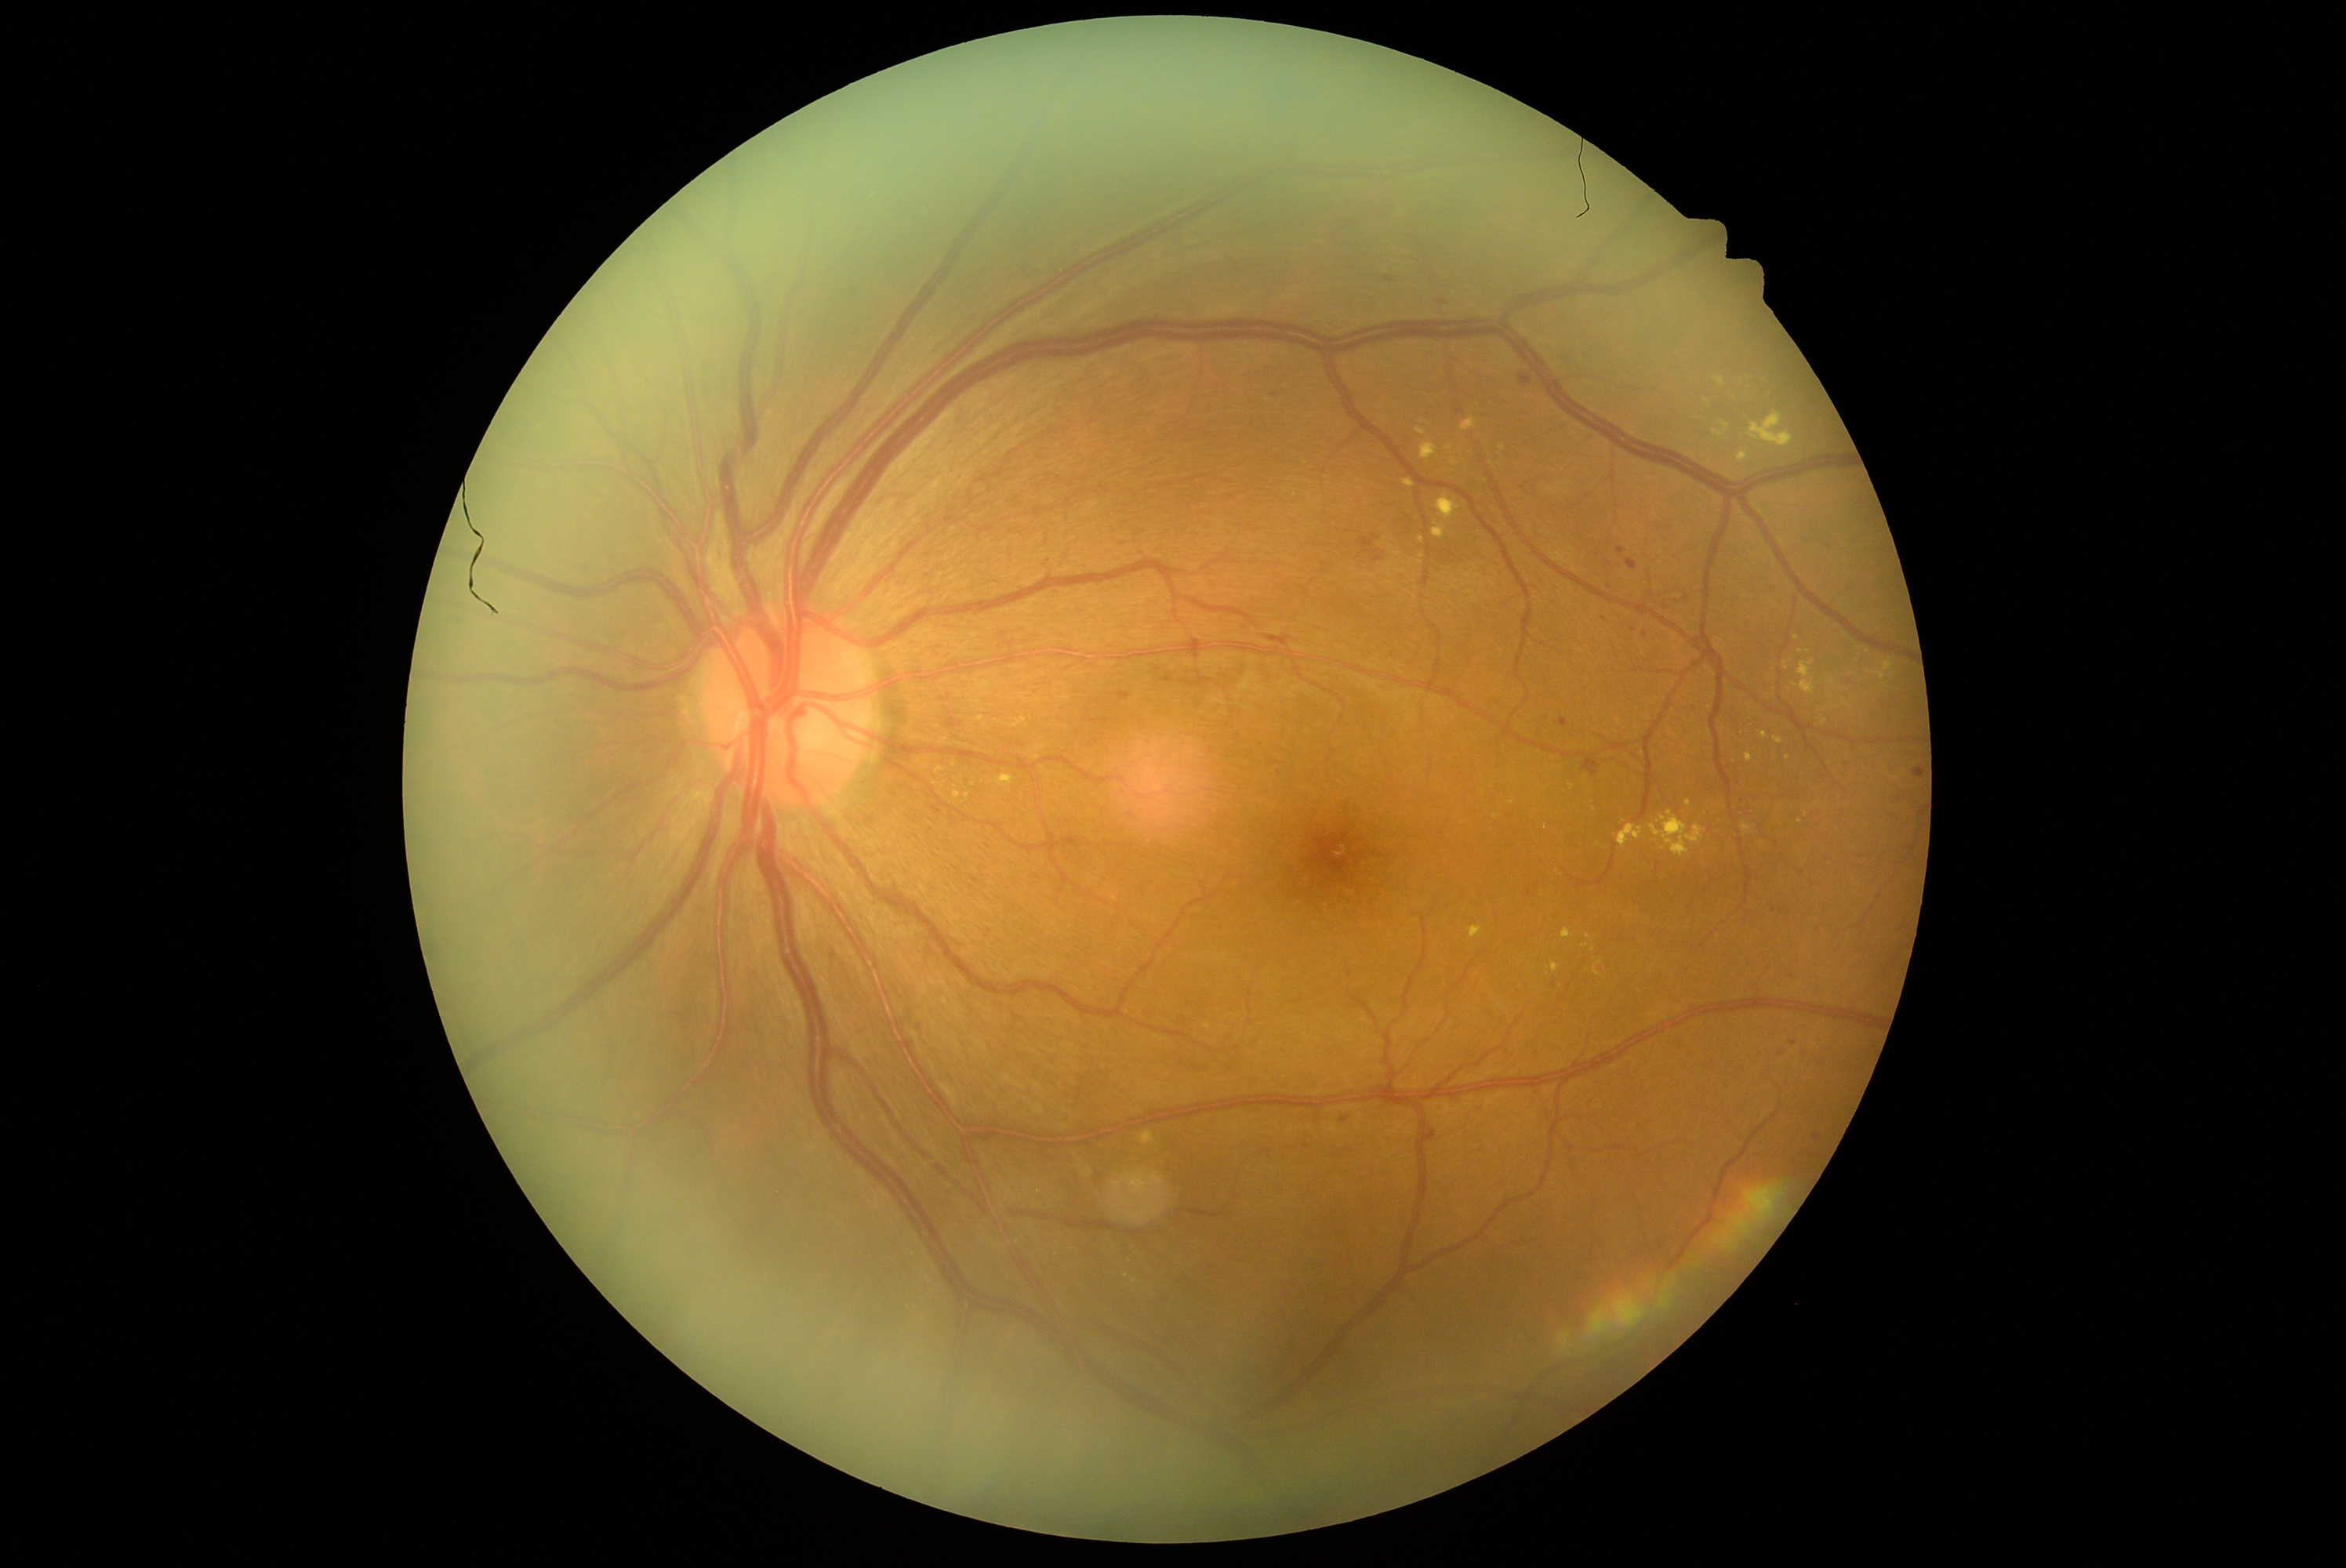 DR grade is moderate non-proliferative diabetic retinopathy (2)
Representative lesions:
EXs (partial): x1=992, y1=771, x2=1017, y2=786, x1=1867, y1=670, x2=1886, y2=681, x1=1826, y1=677, x2=1839, y2=686, x1=1798, y1=659, x2=1825, y2=695, x1=1086, y1=1169, x2=1094, y2=1175, x1=1737, y1=451, x2=1749, y2=462, x1=1125, y1=1257, x2=1133, y2=1266, x1=1843, y1=699, x2=1853, y2=710, x1=1760, y1=733, x2=1768, y2=739
Small EXs near Point(1420, 563), Point(1766, 381), Point(1642, 753), Point(1689, 803), Point(1707, 401), Point(1422, 422)